Wide-field fundus photograph of an infant. 130° field of view (Clarity RetCam 3): 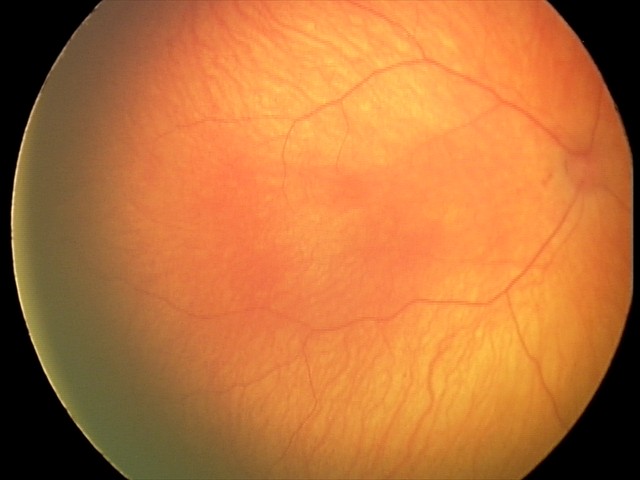
Q: What was the screening finding?
A: normal fundus examination